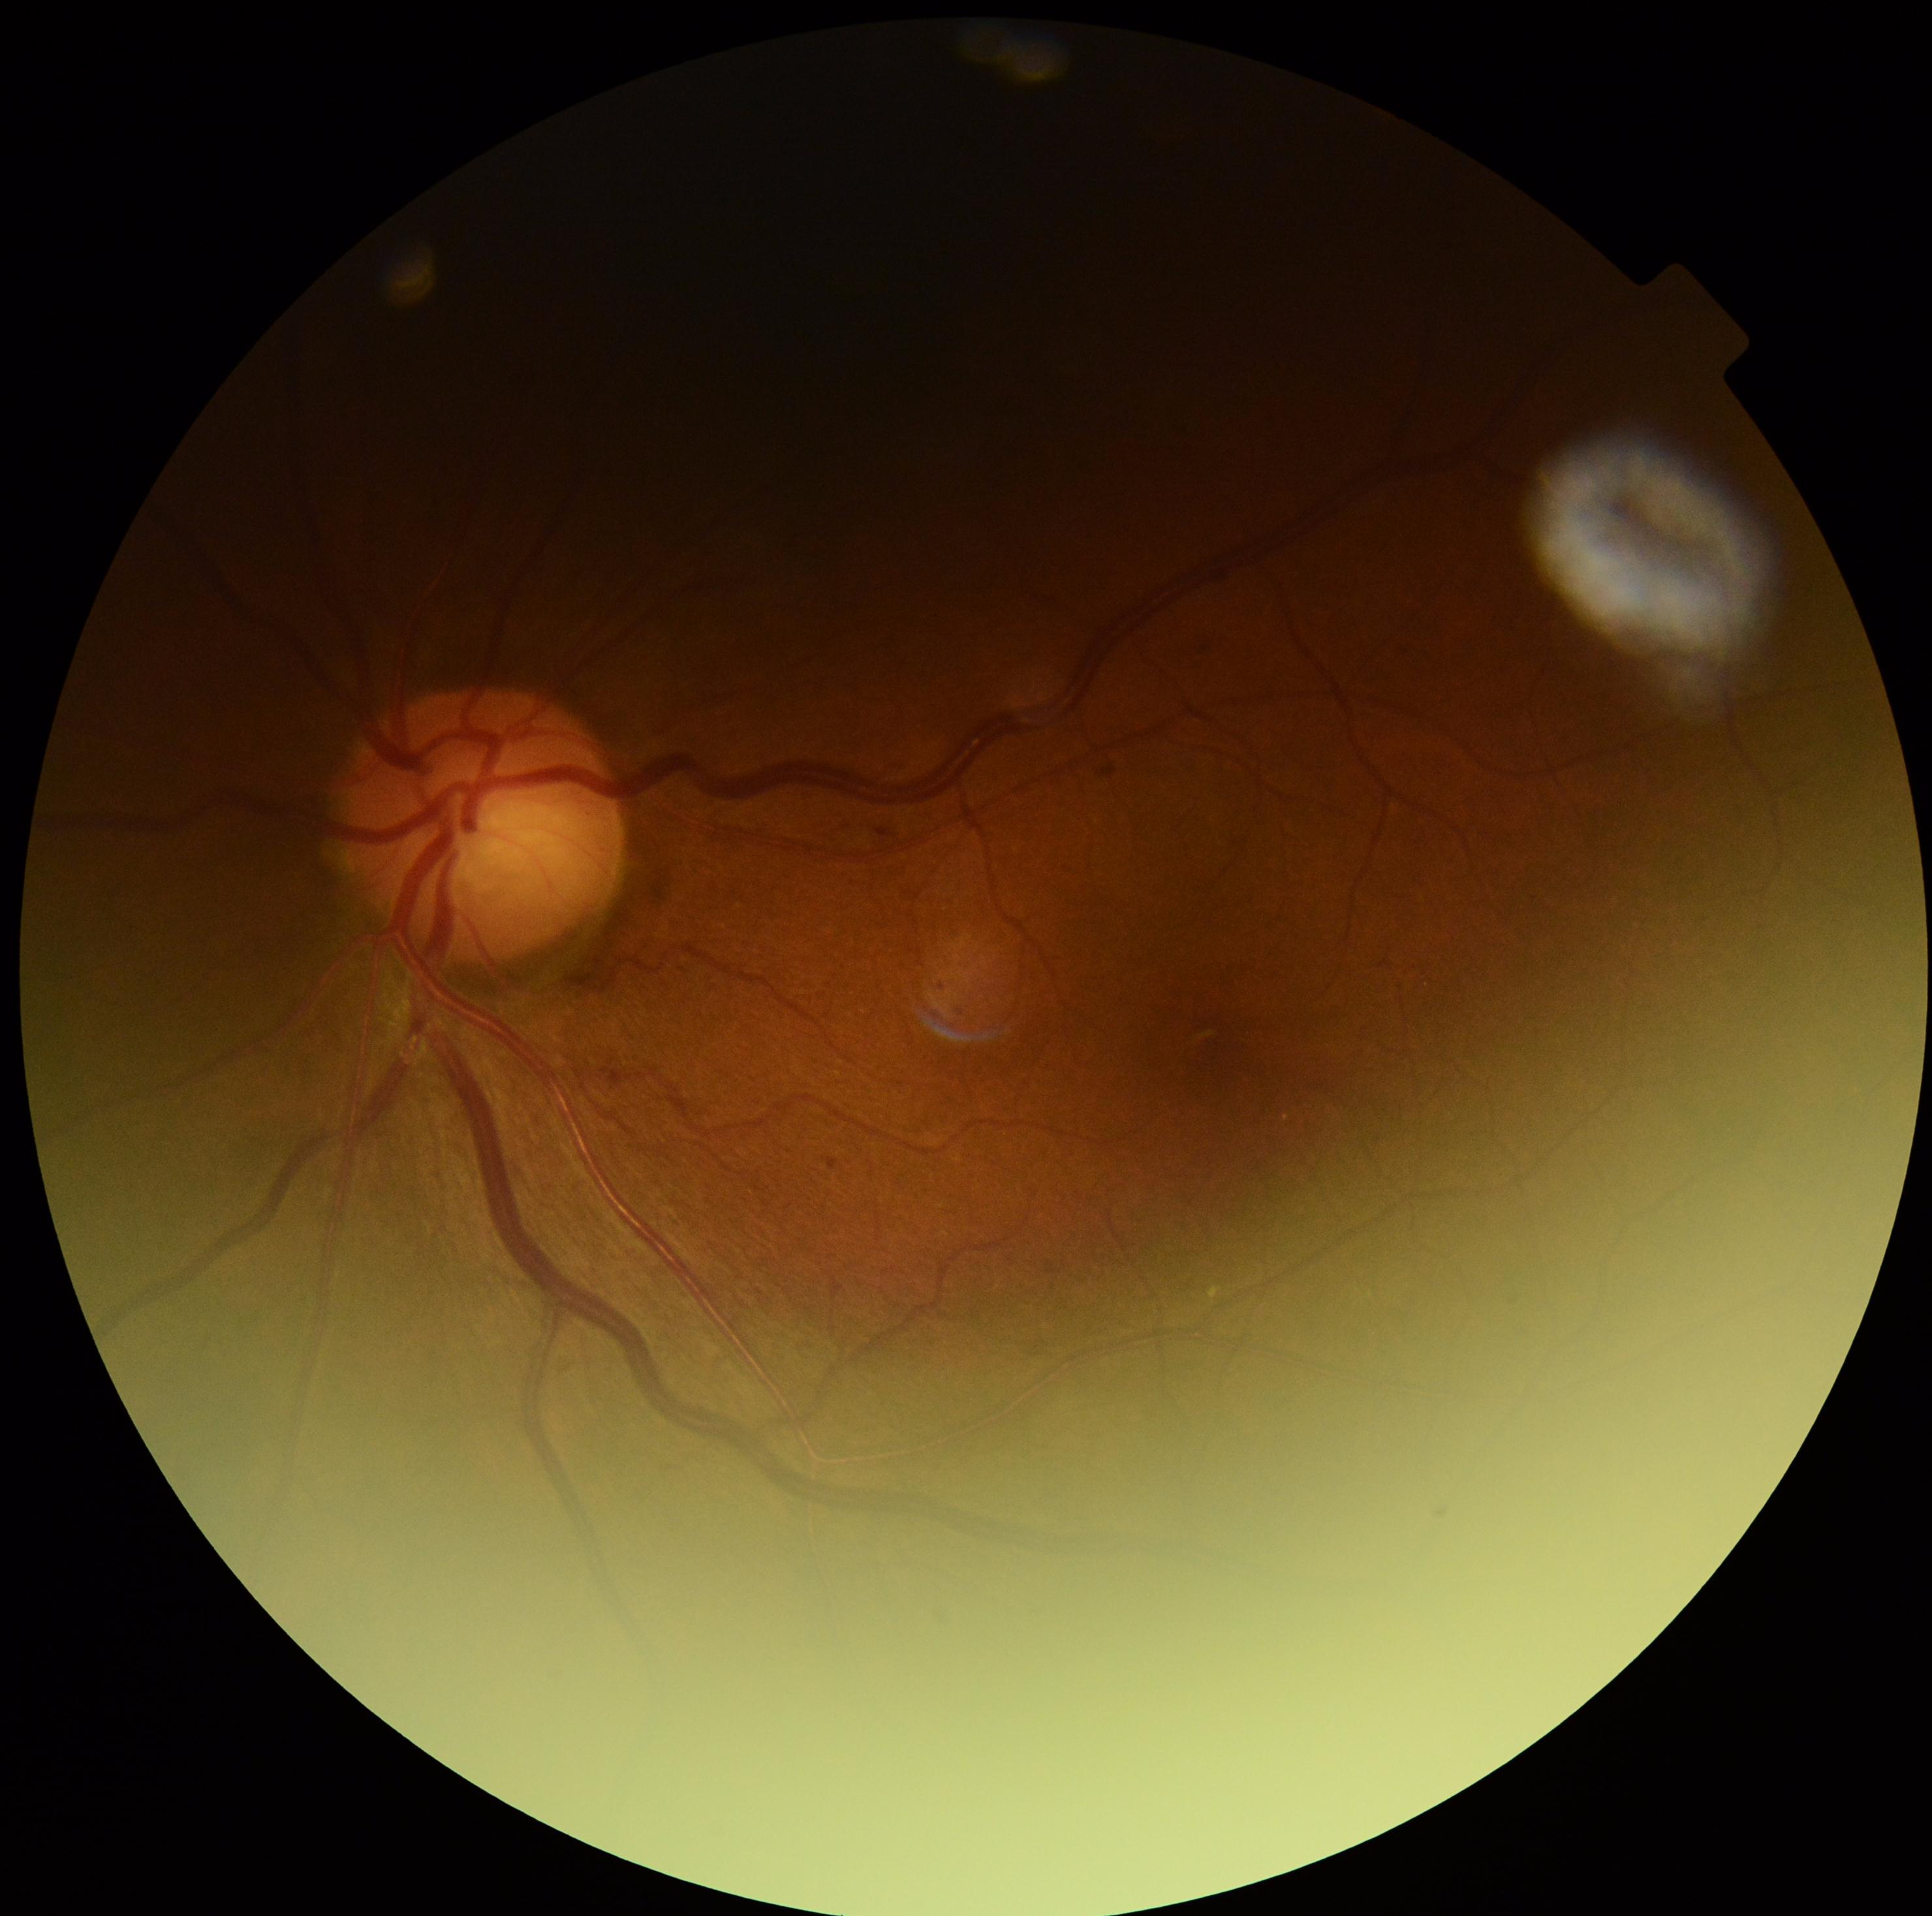

DR grade: 1 (mild NPDR). The retinopathy is classified as non-proliferative diabetic retinopathy.